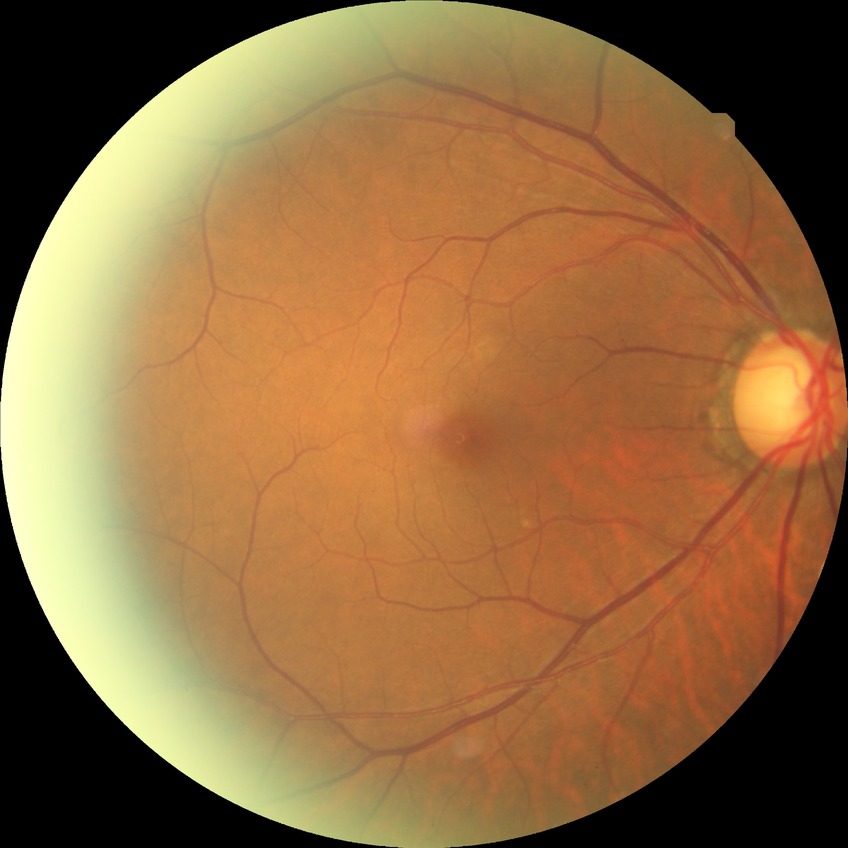
Diabetic retinopathy (DR) is no diabetic retinopathy (NDR).